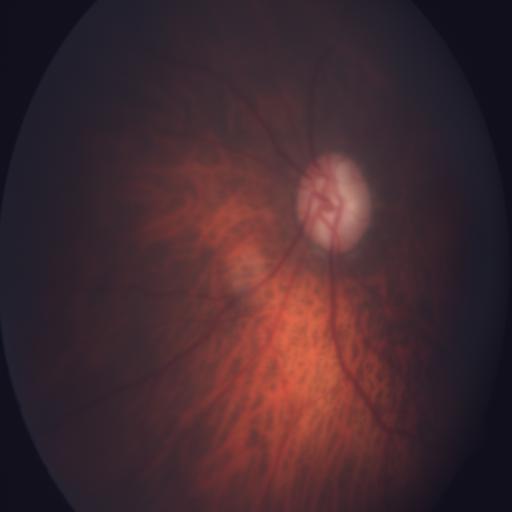

Two findings. Retinal fundus photograph demonstrating myopia and optic disc cupping.